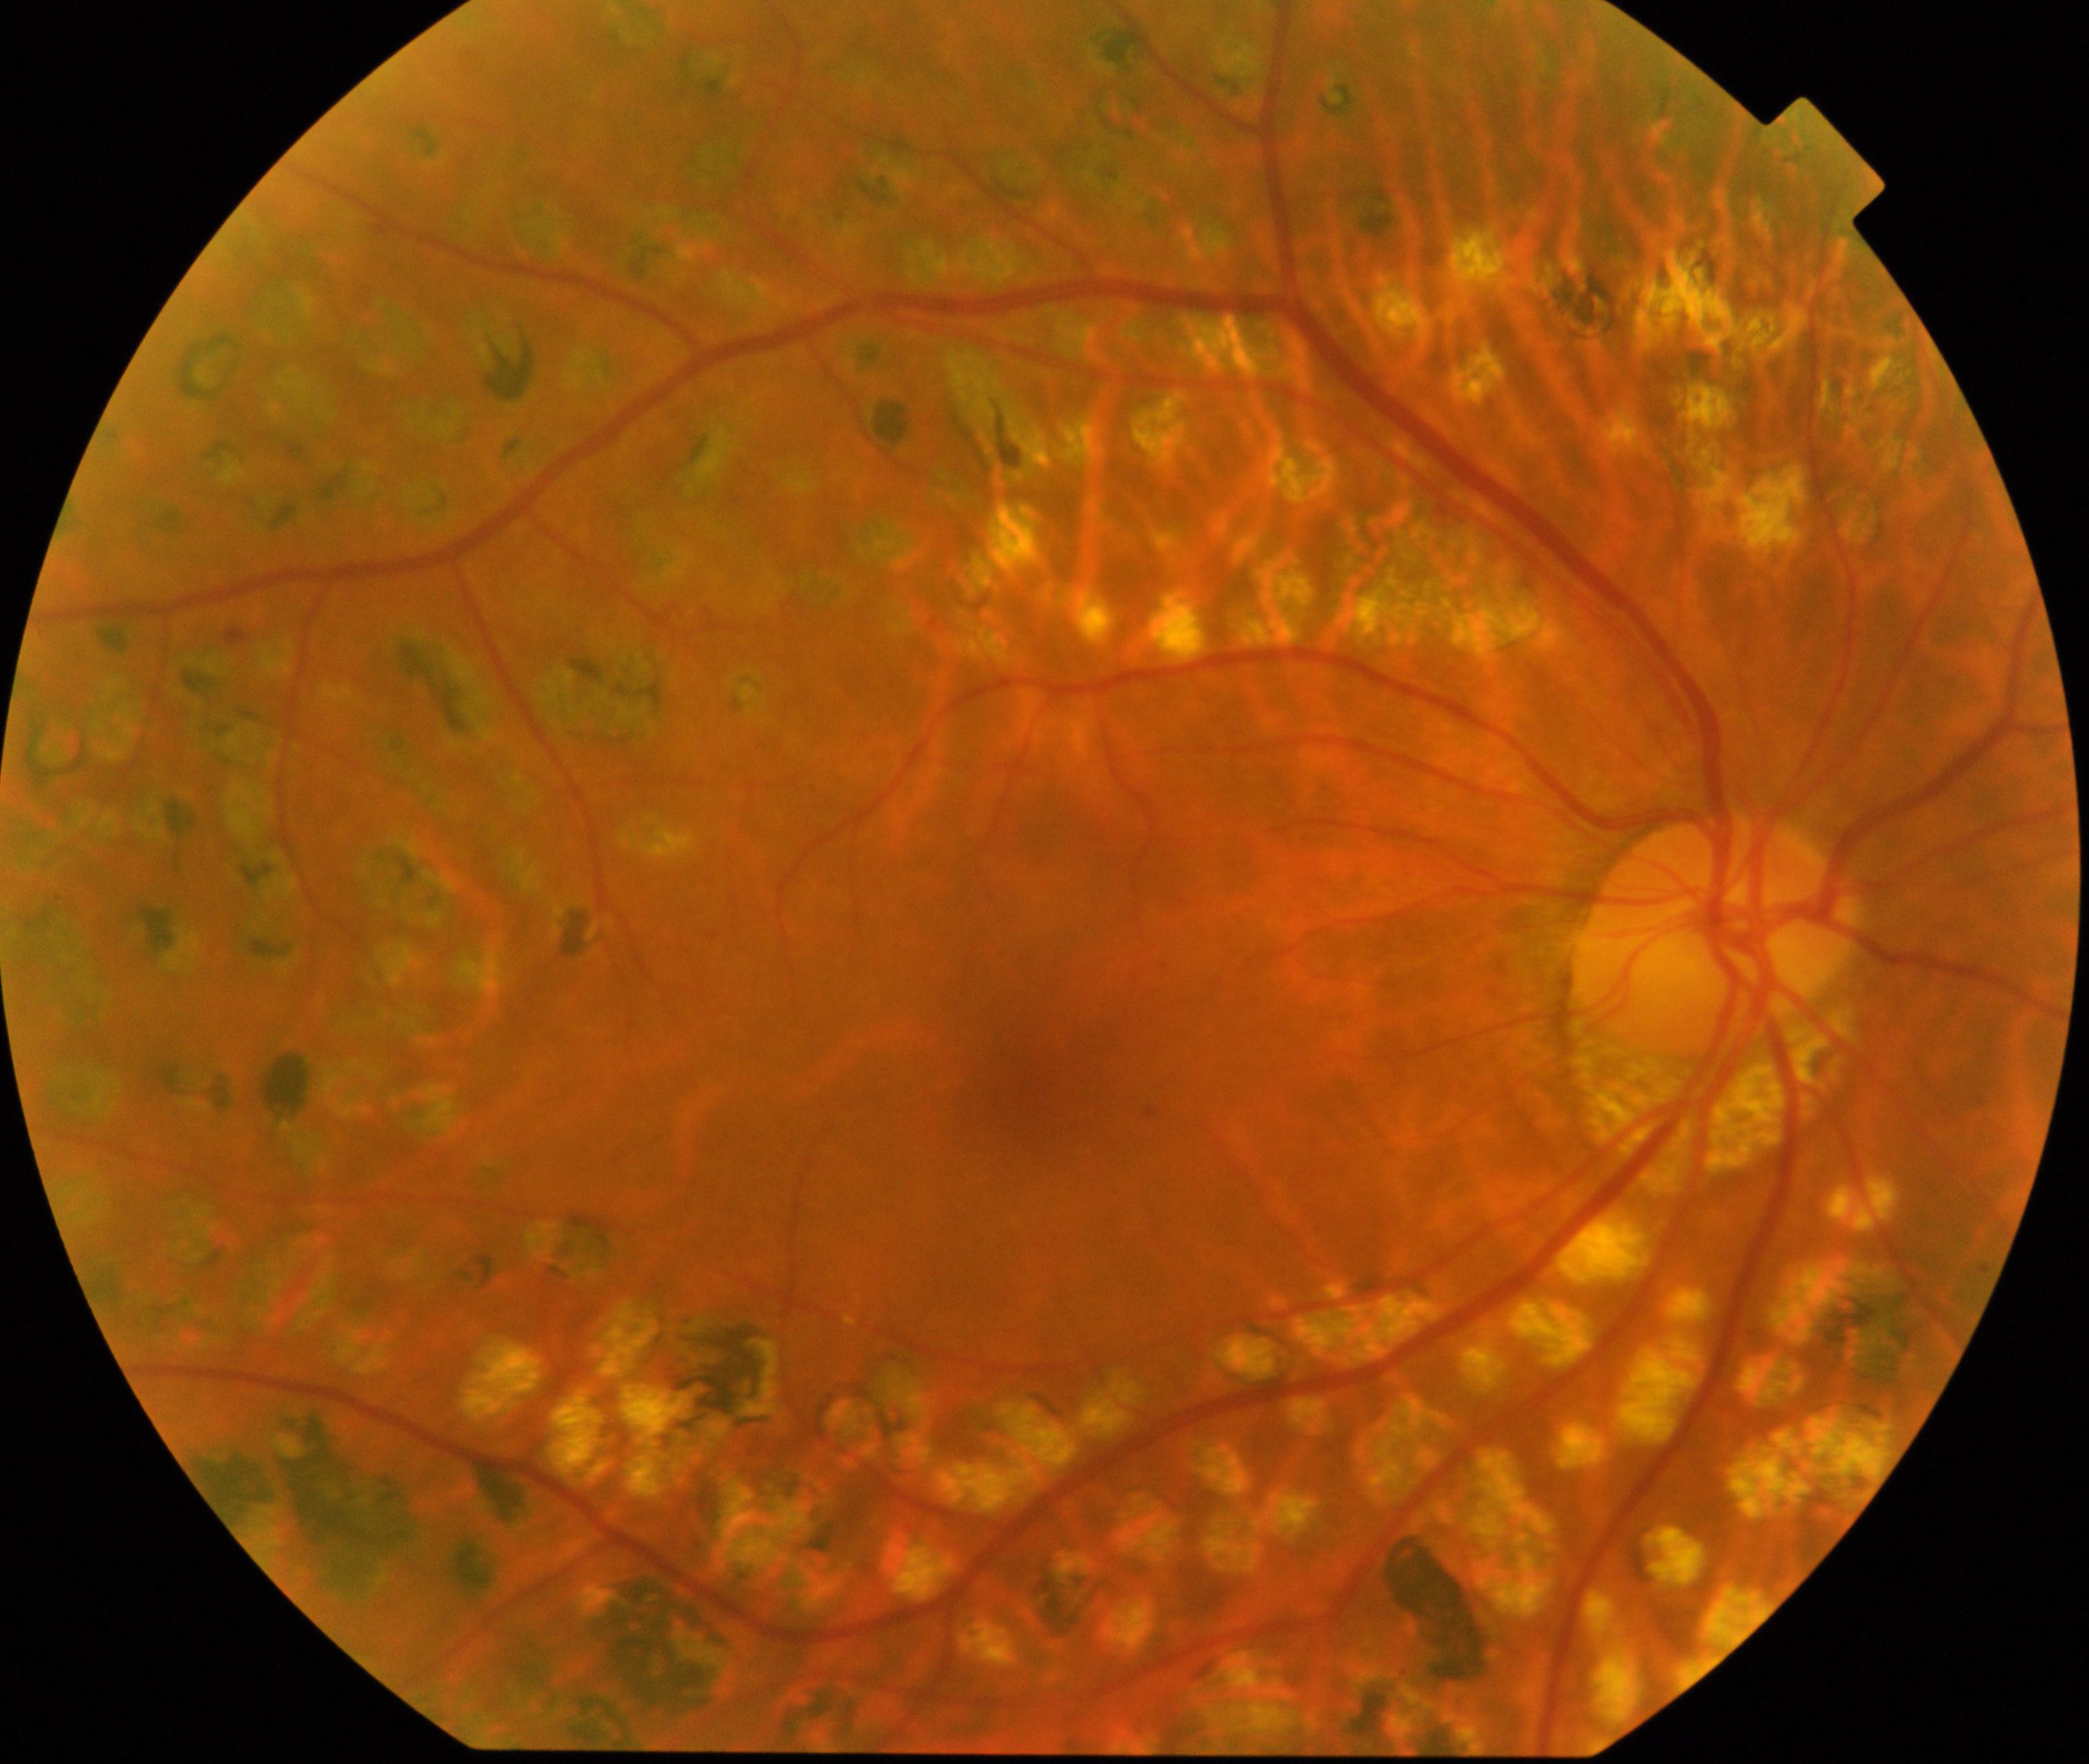
The image shows laser spots.